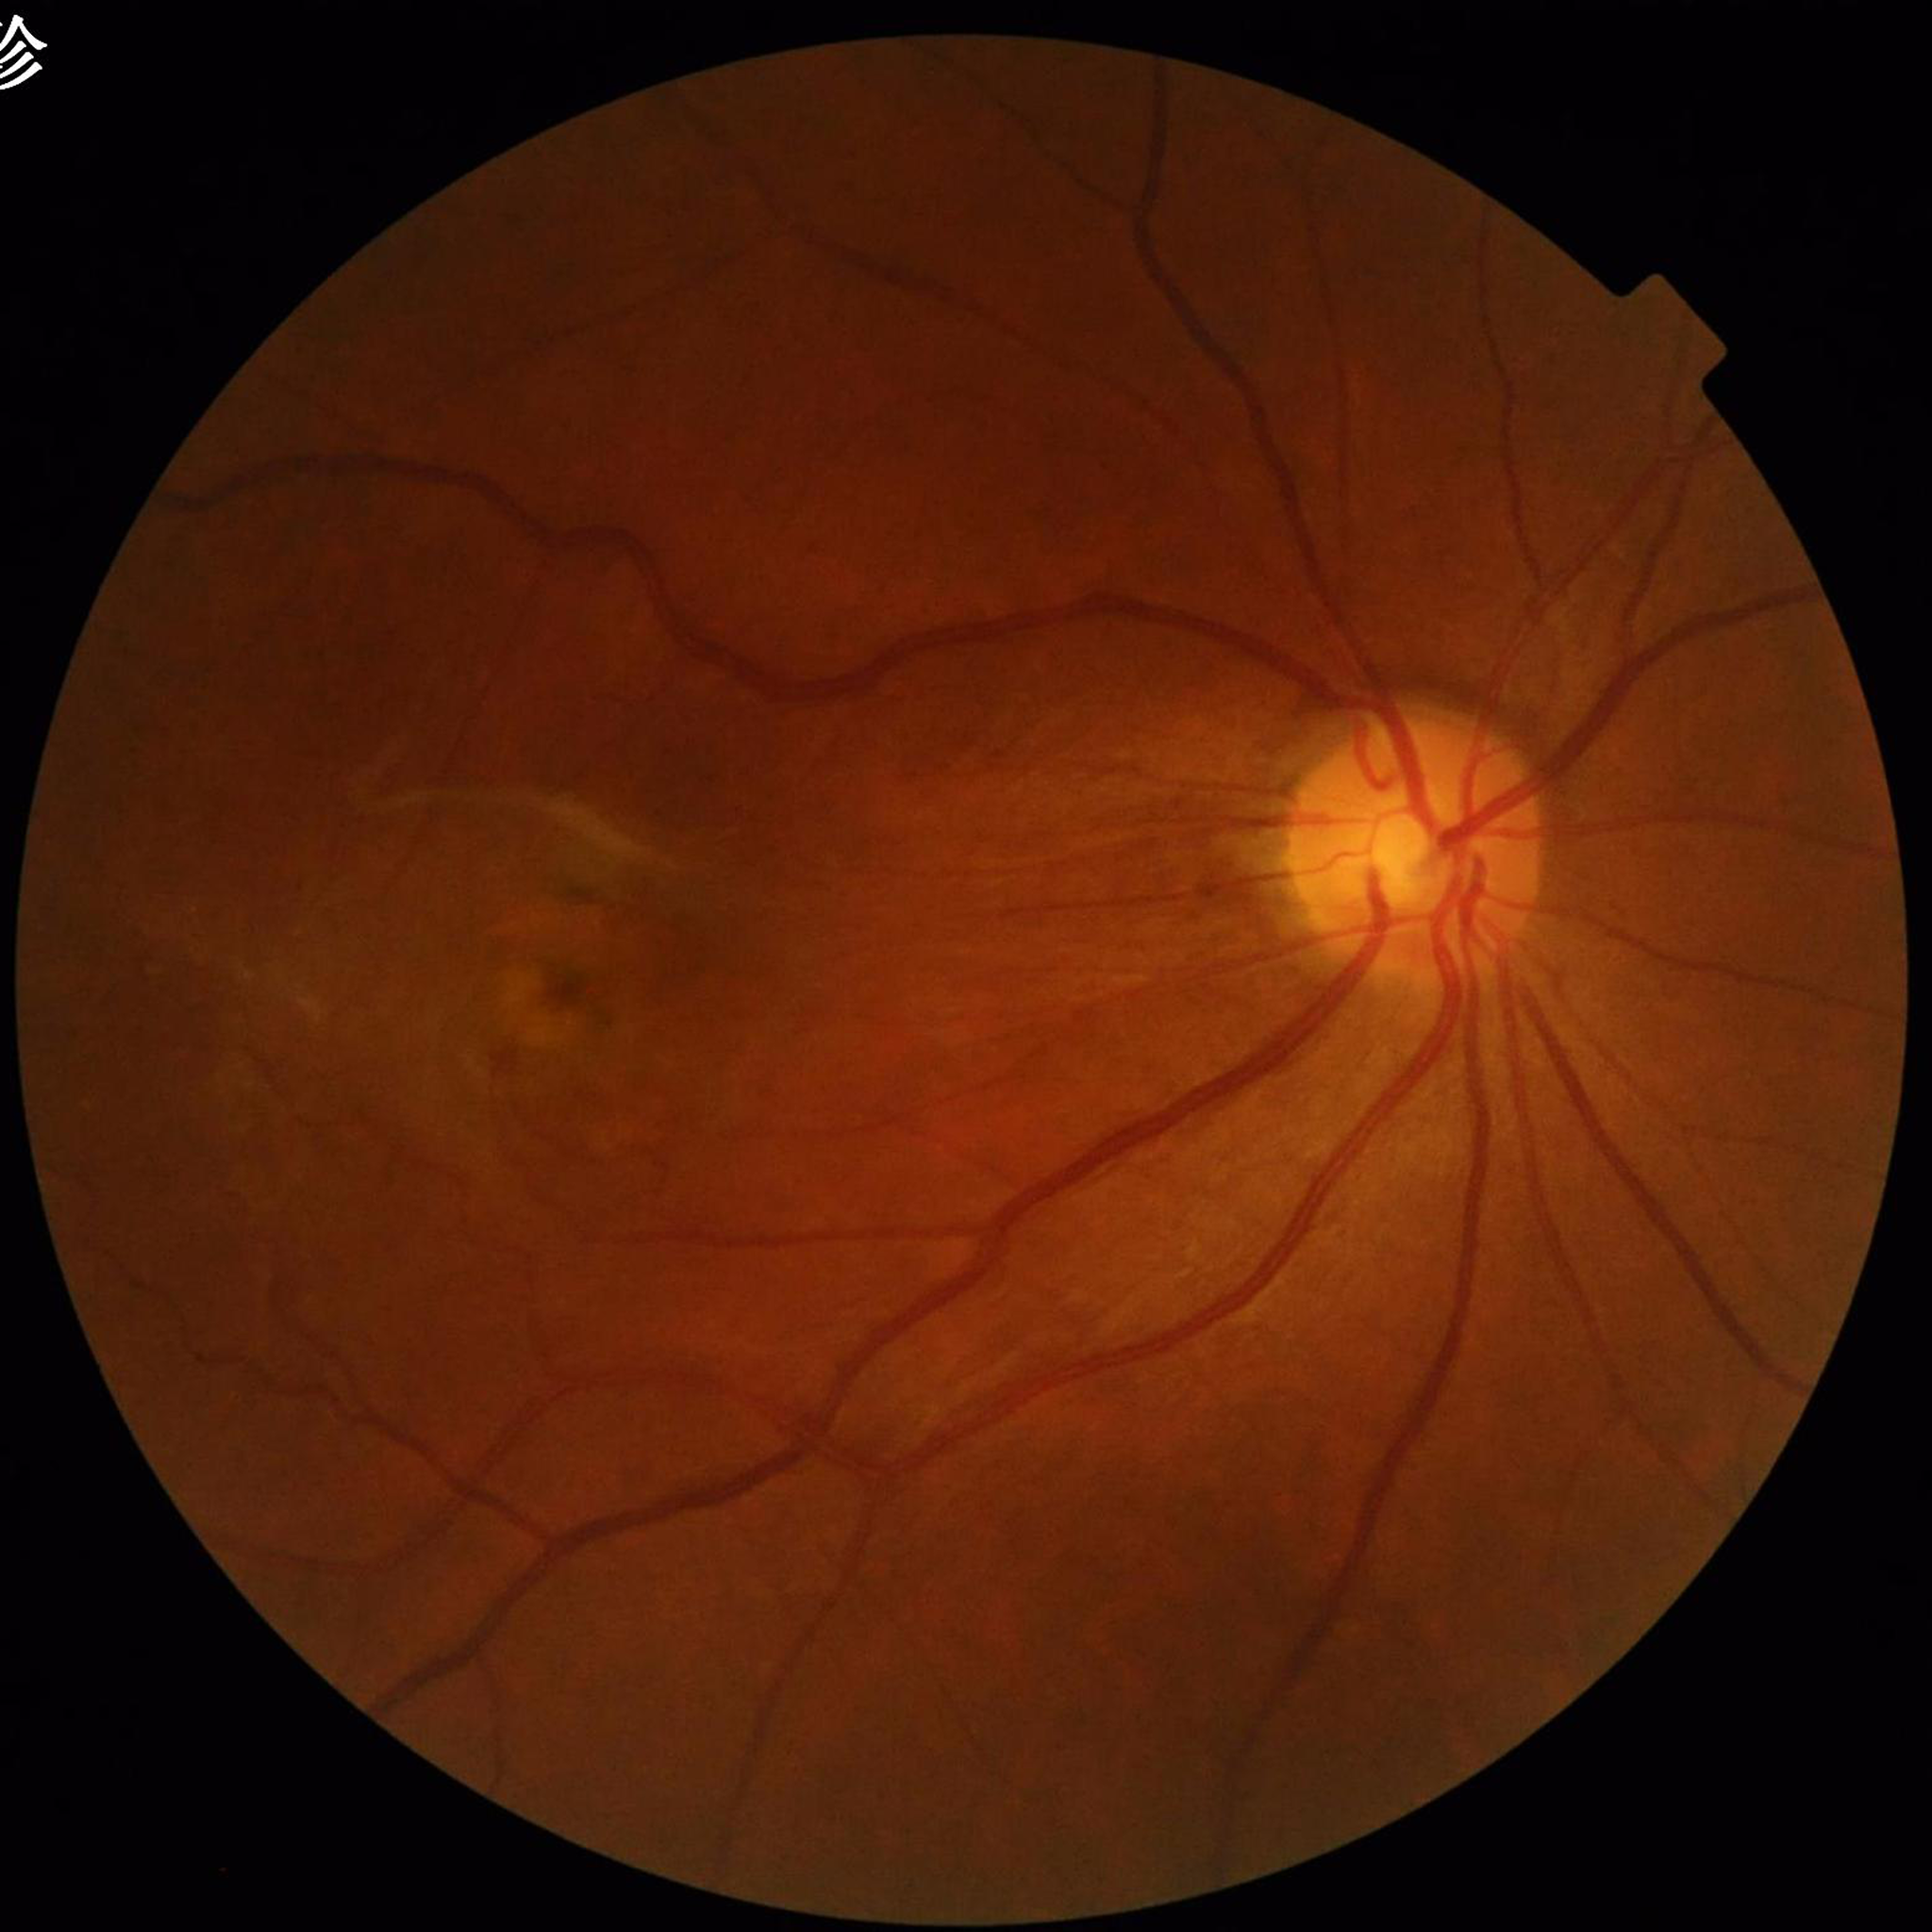 Fundus image of an eye with AMD.